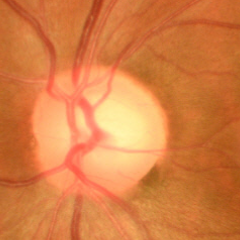 Glaucomatous optic neuropathy is present. Glaucoma stage: early-stage glaucoma.